Acquired on the Clarity RetCam 3. RetCam wide-field infant fundus image — 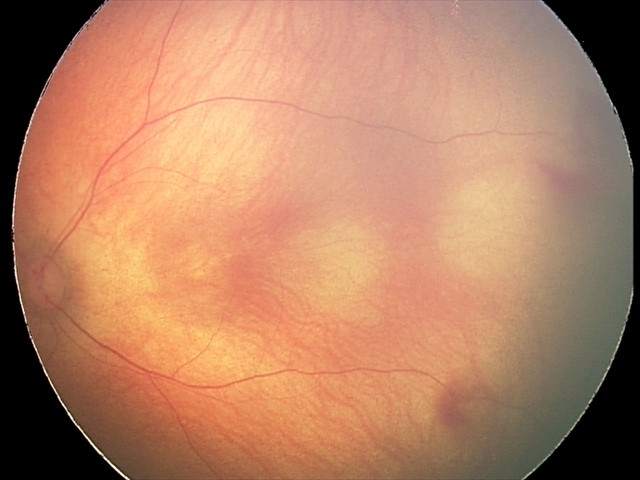

Screening examination consistent with retinal hemorrhages.